45° field of view:
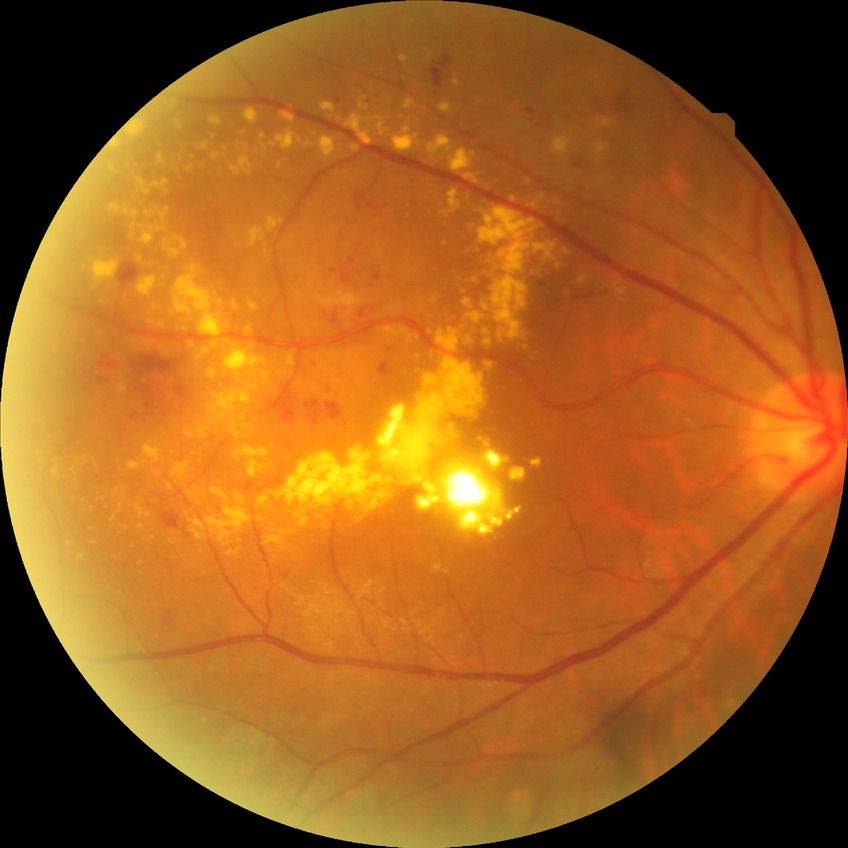
Assessment:
• diabetic retinopathy (DR): SDR (simple diabetic retinopathy)